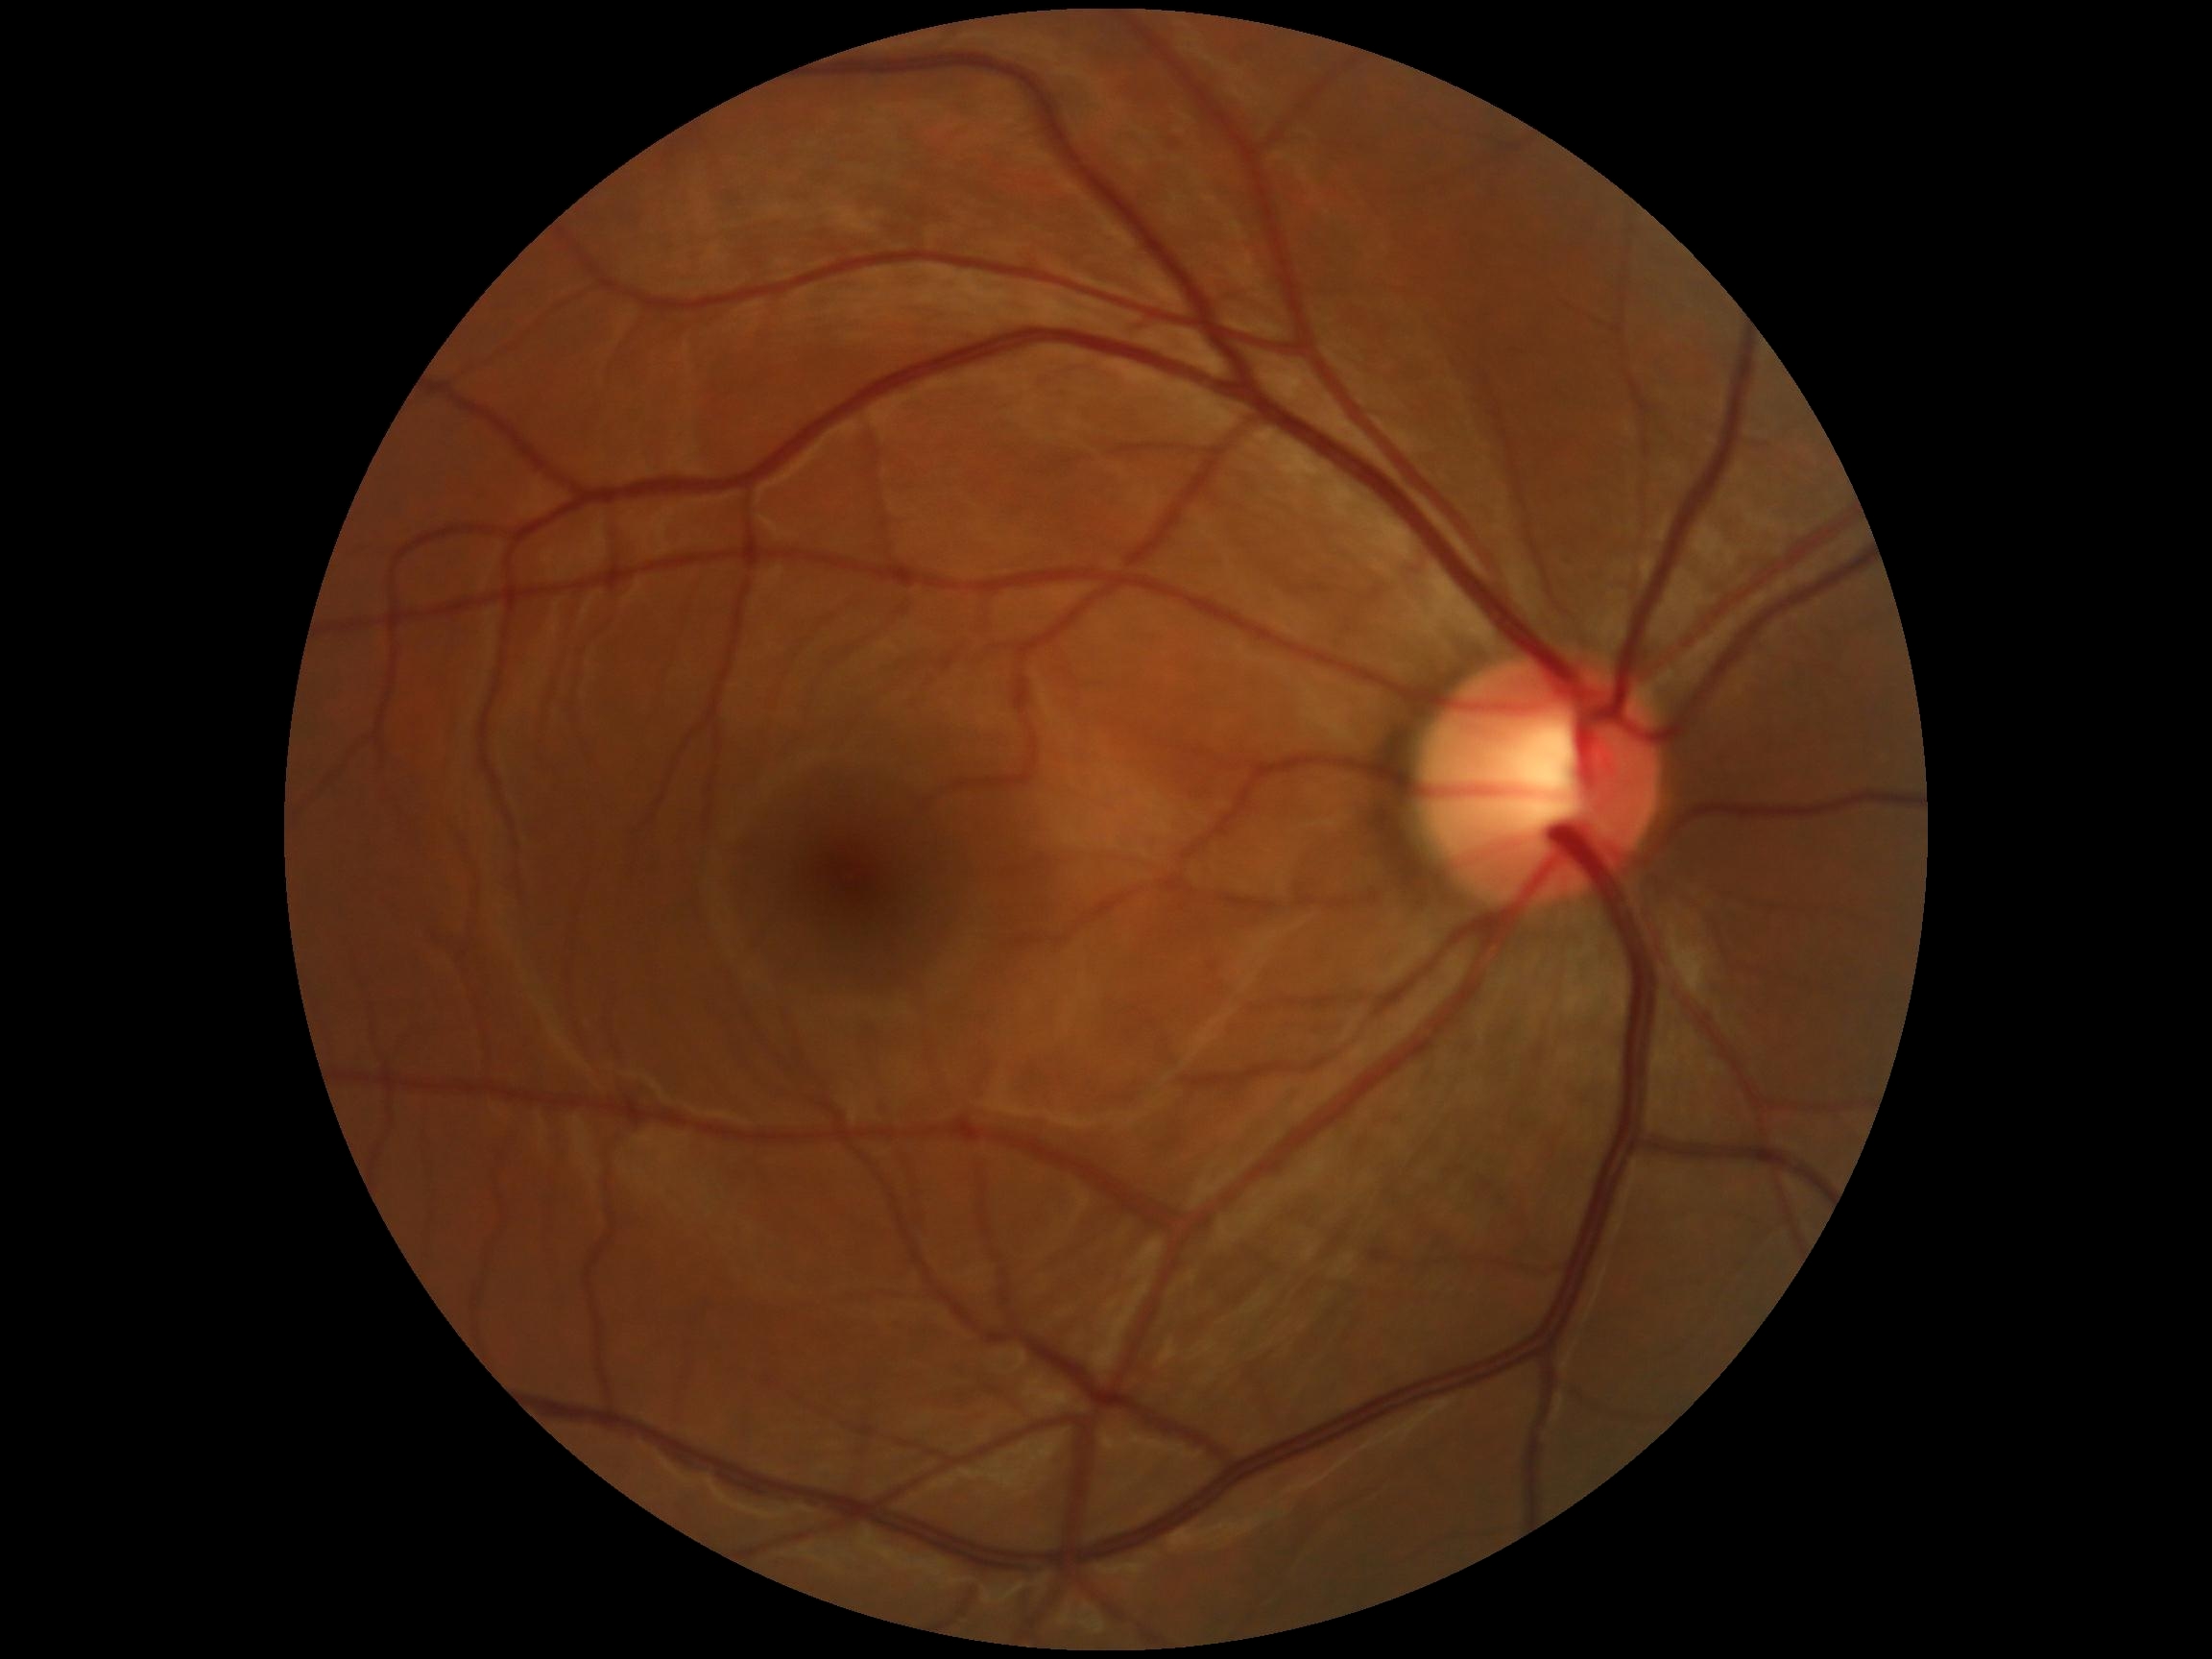 Diabetic retinopathy (DR) is grade 0 (no apparent retinopathy).